2352 x 1568 pixels; 45° field of view: 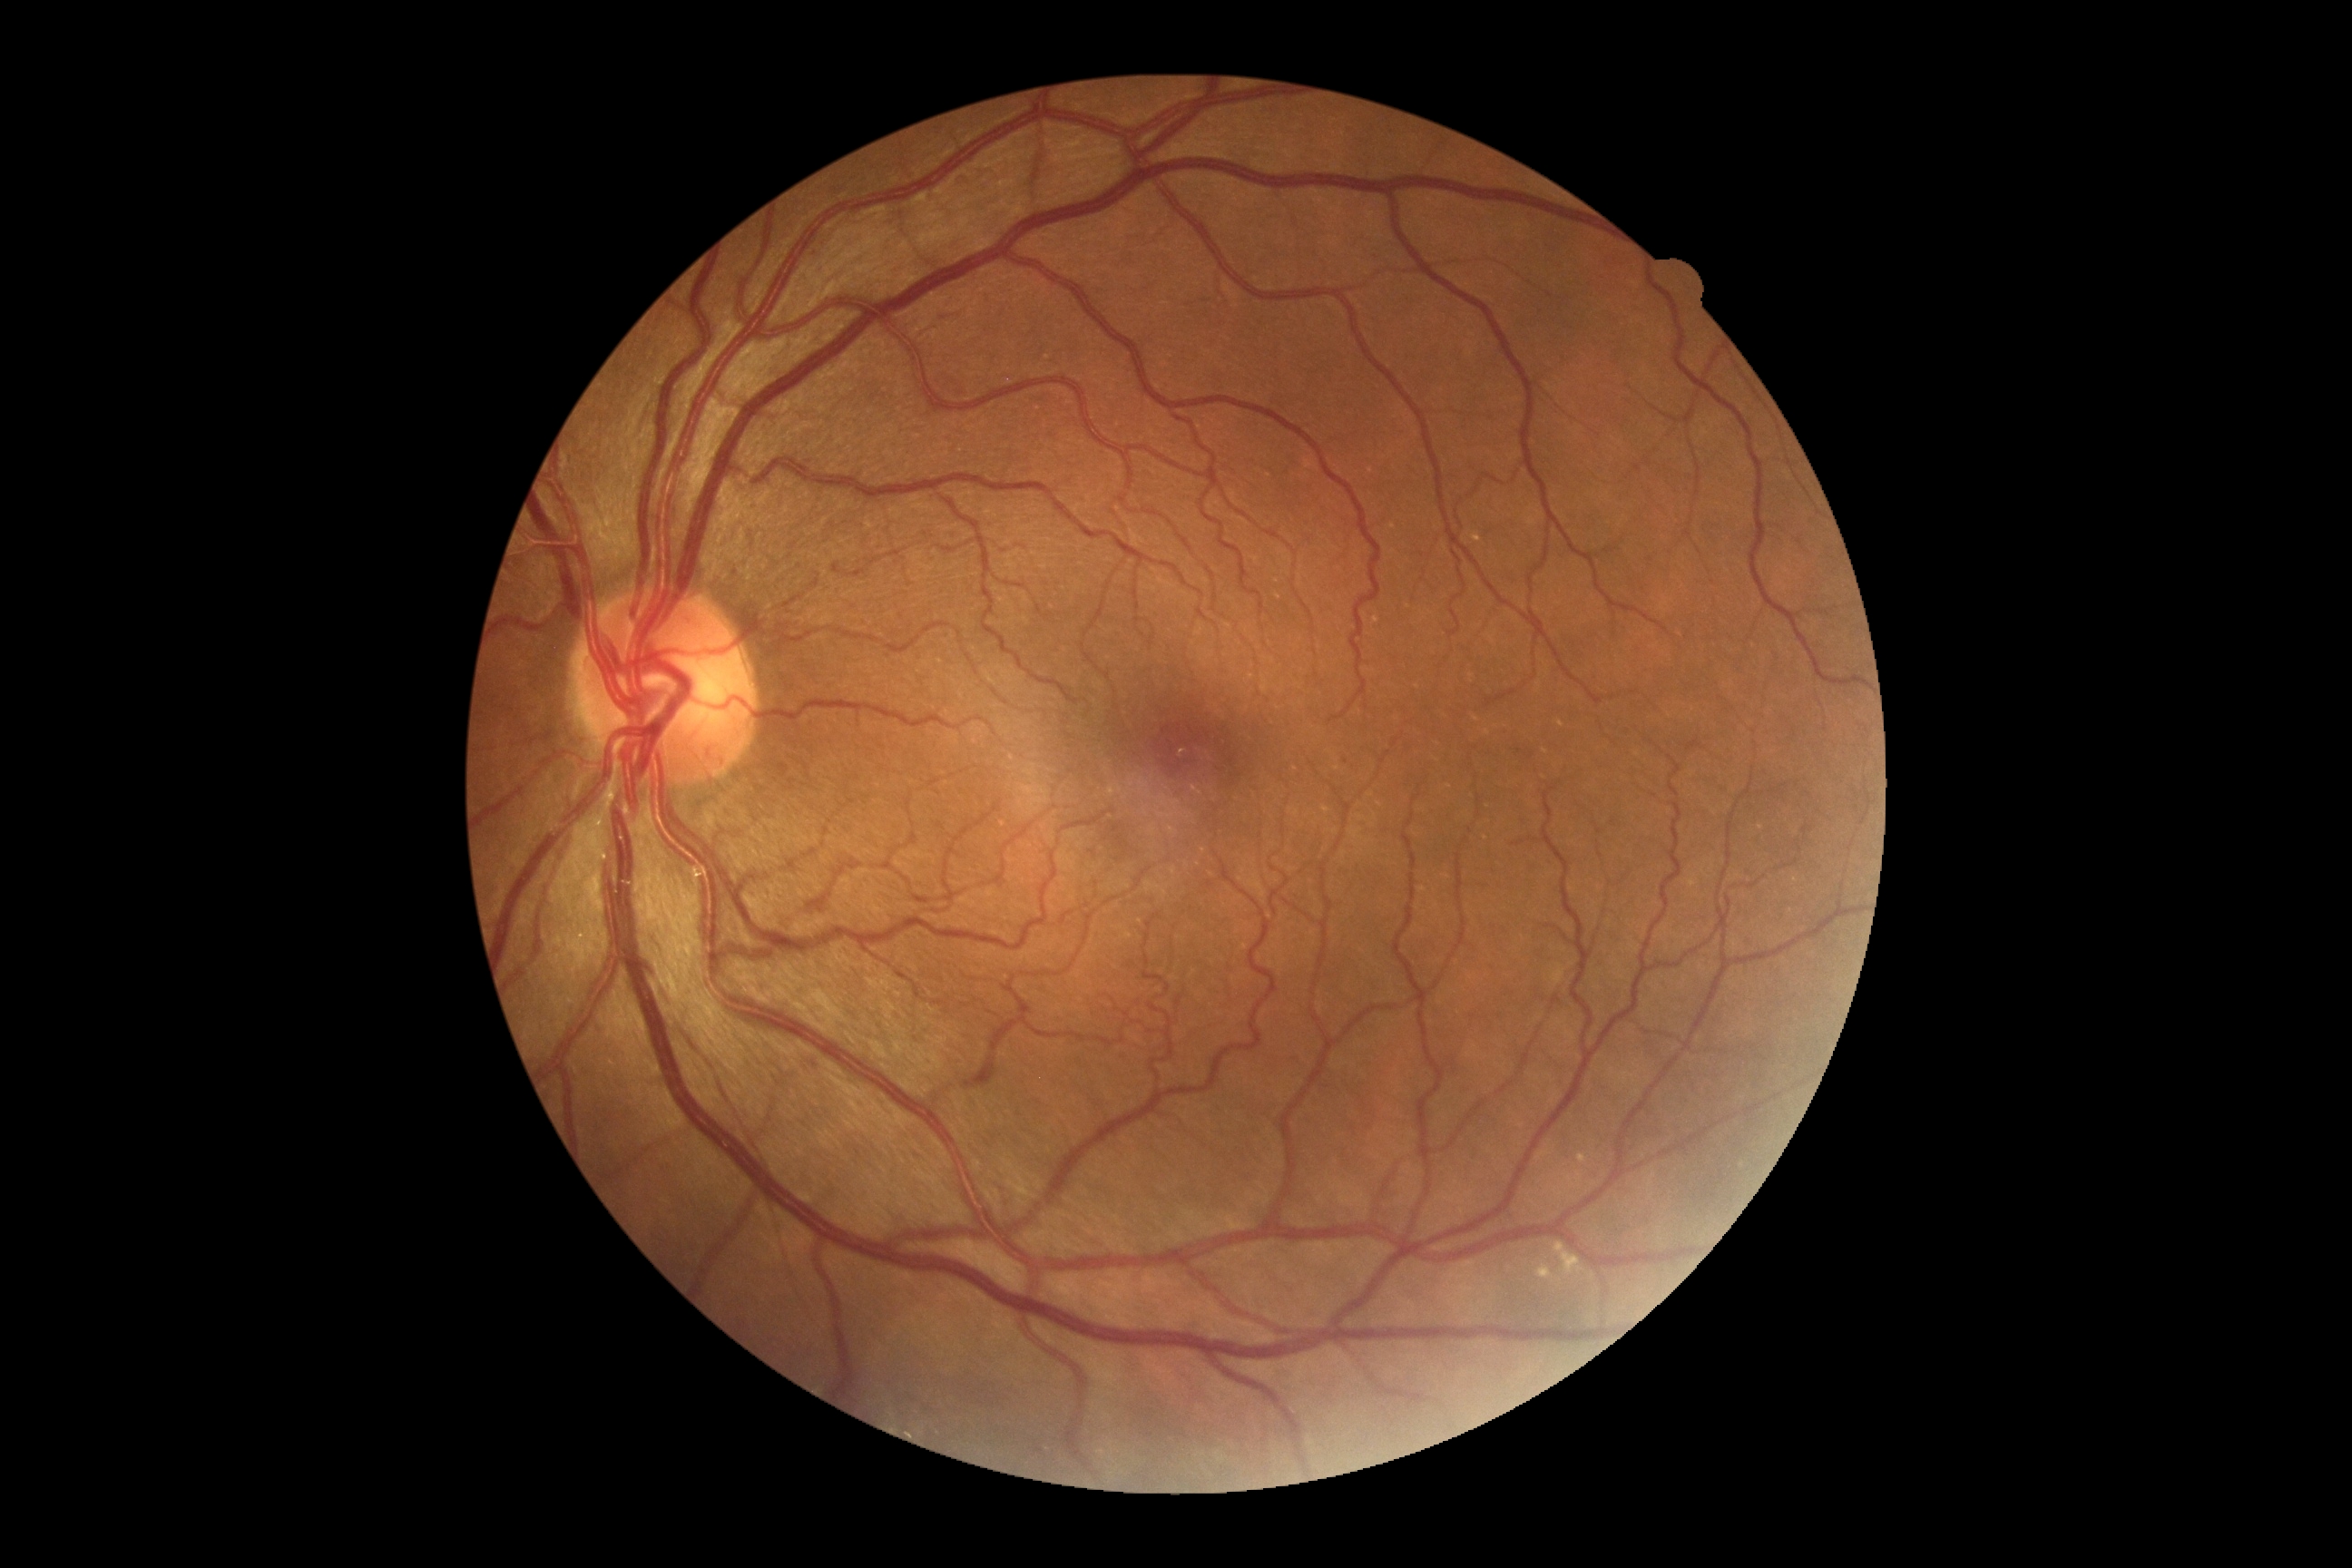

{"dr_grade": "moderate non-proliferative diabetic retinopathy (grade 2)"}